NIDEK AFC-230
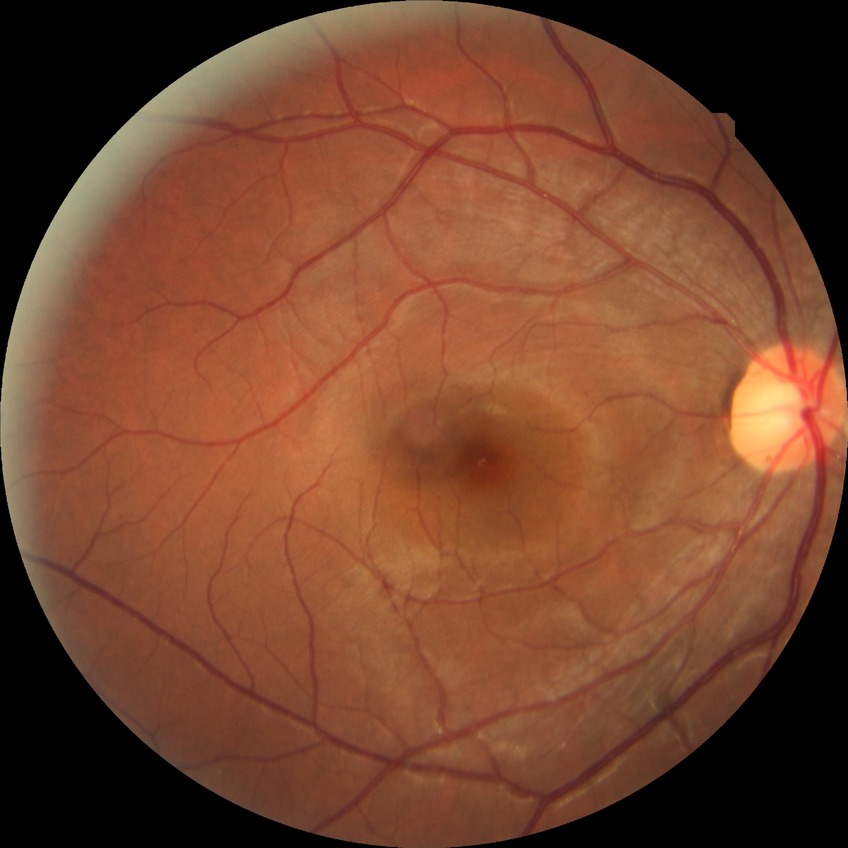 Diabetic retinopathy (DR): NDR (no diabetic retinopathy).